RetCam wide-field infant fundus image — 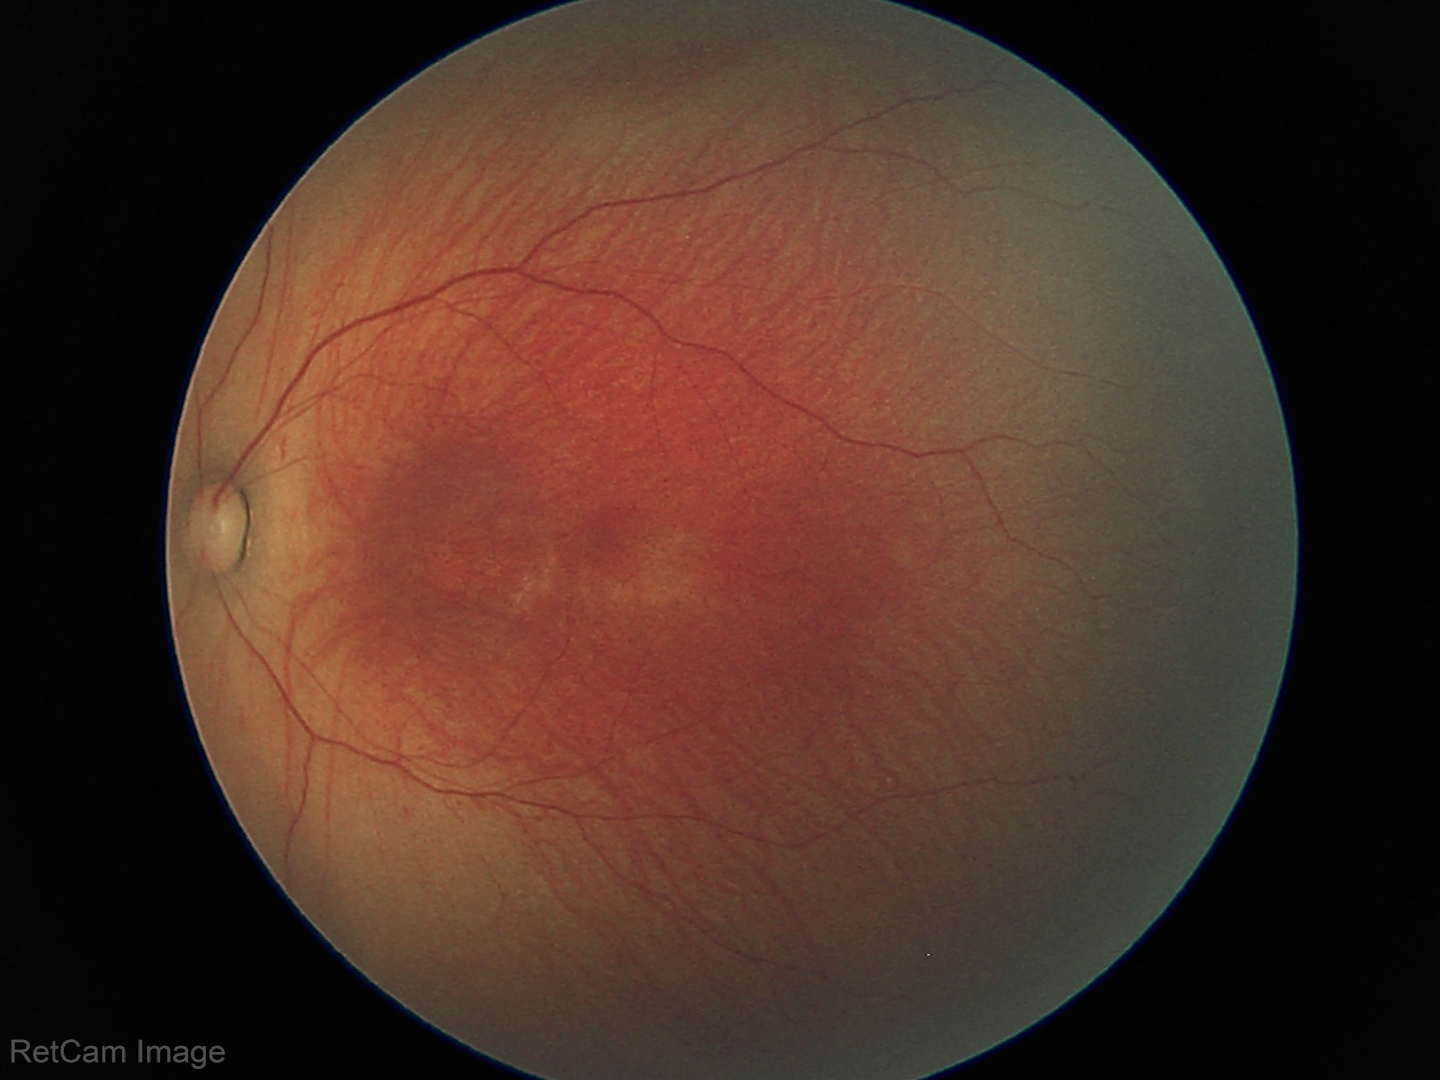

Q: What is the diagnosis from this examination?
A: retinopathy of prematurity (ROP) stage 1